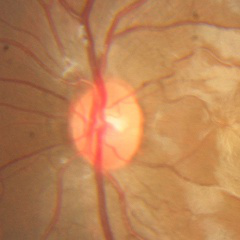

Showing no glaucoma.